Image size 2352x1568; 45-degree field of view — 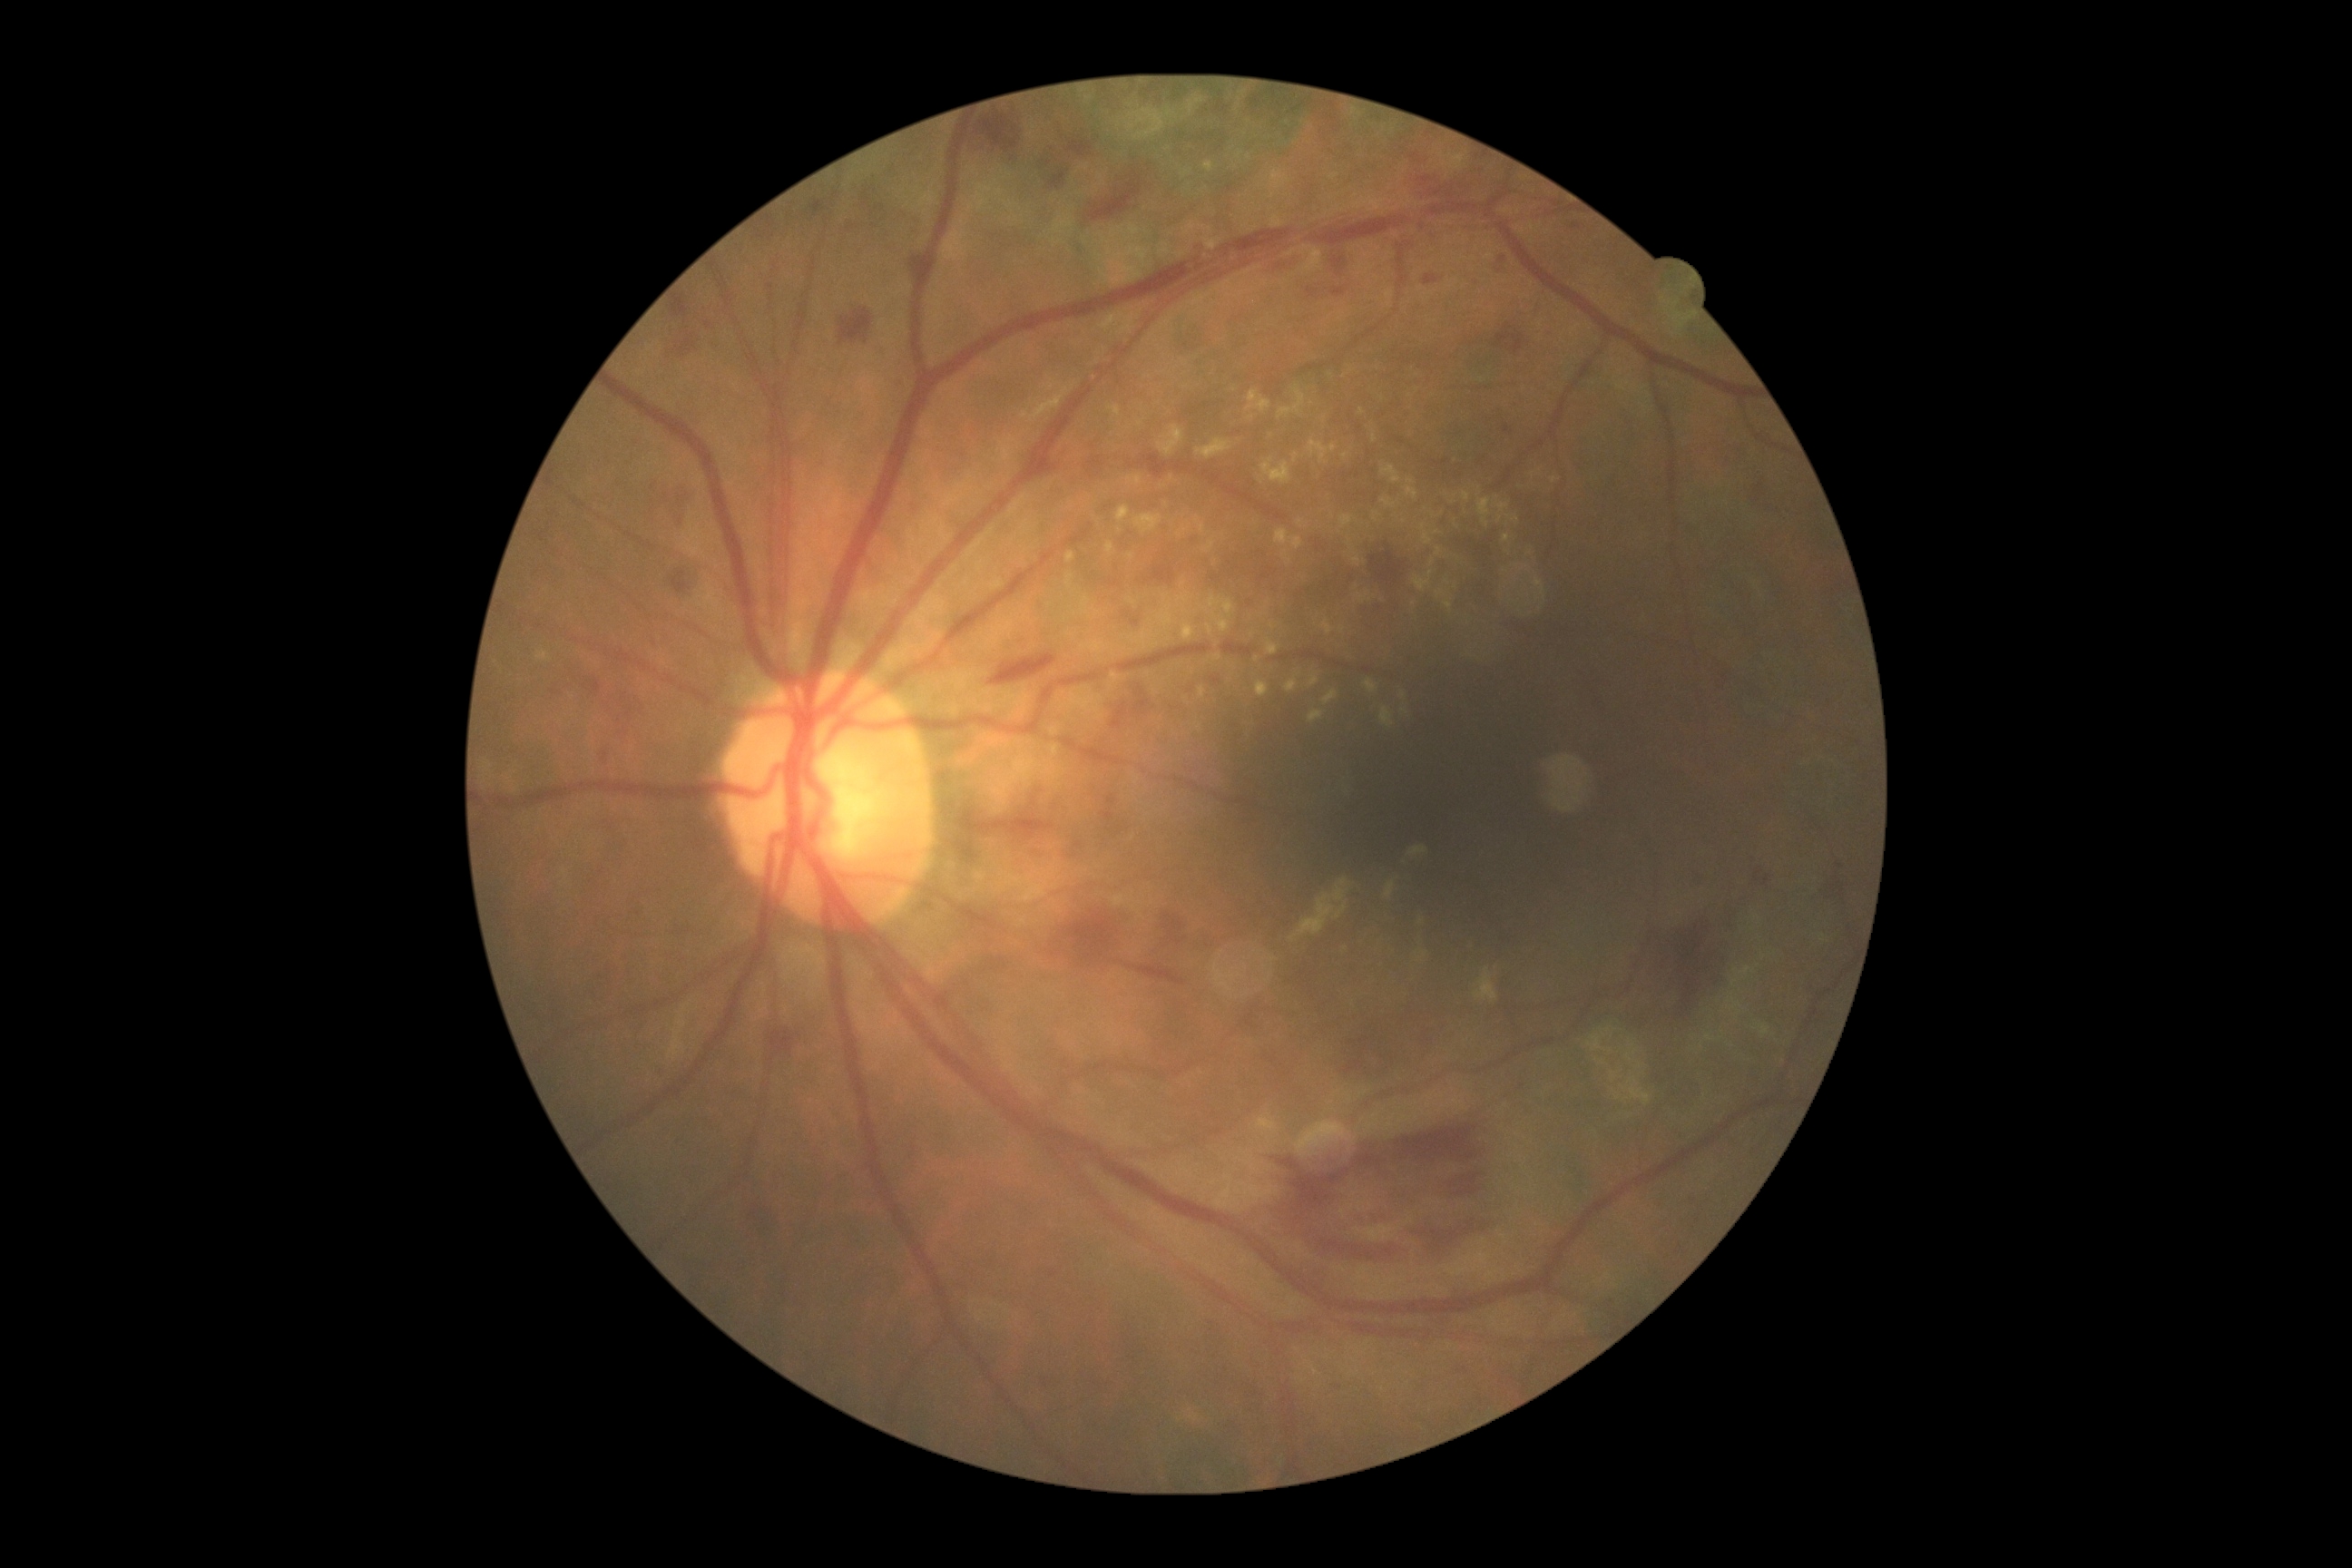
DR: moderate non-proliferative diabetic retinopathy (grade 2).